2048 by 1536 pixels: 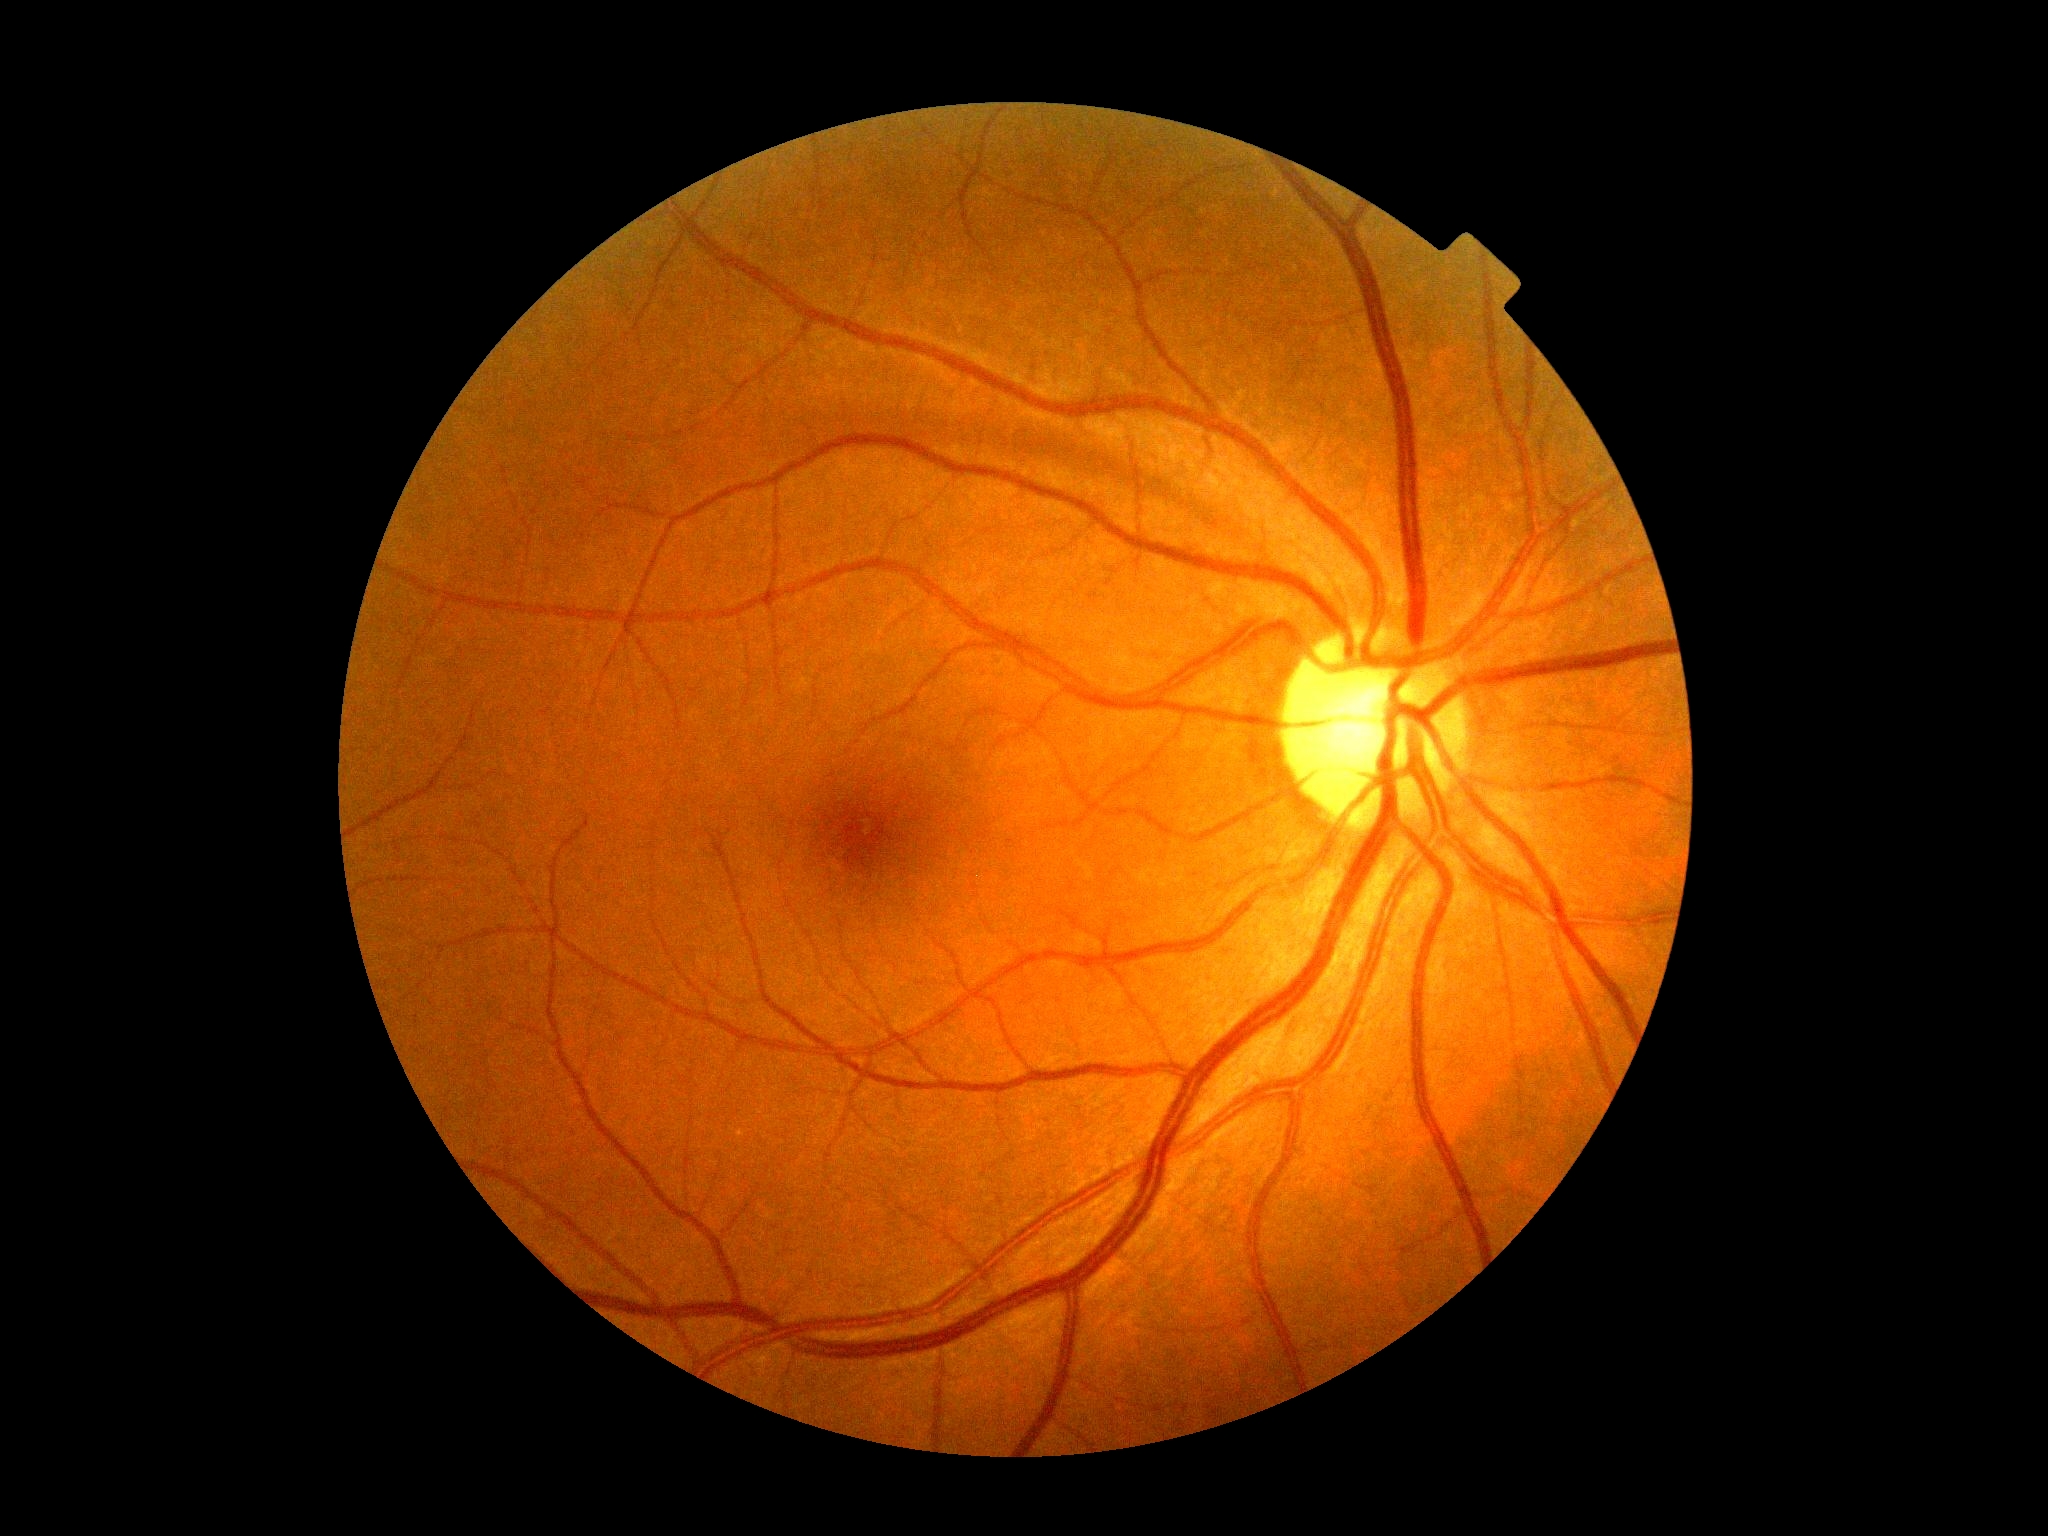

Diabetic retinopathy grade is 0 (no apparent retinopathy).